Wide-field fundus photograph from neonatal ROP screening. Acquired on the Natus RetCam Envision:
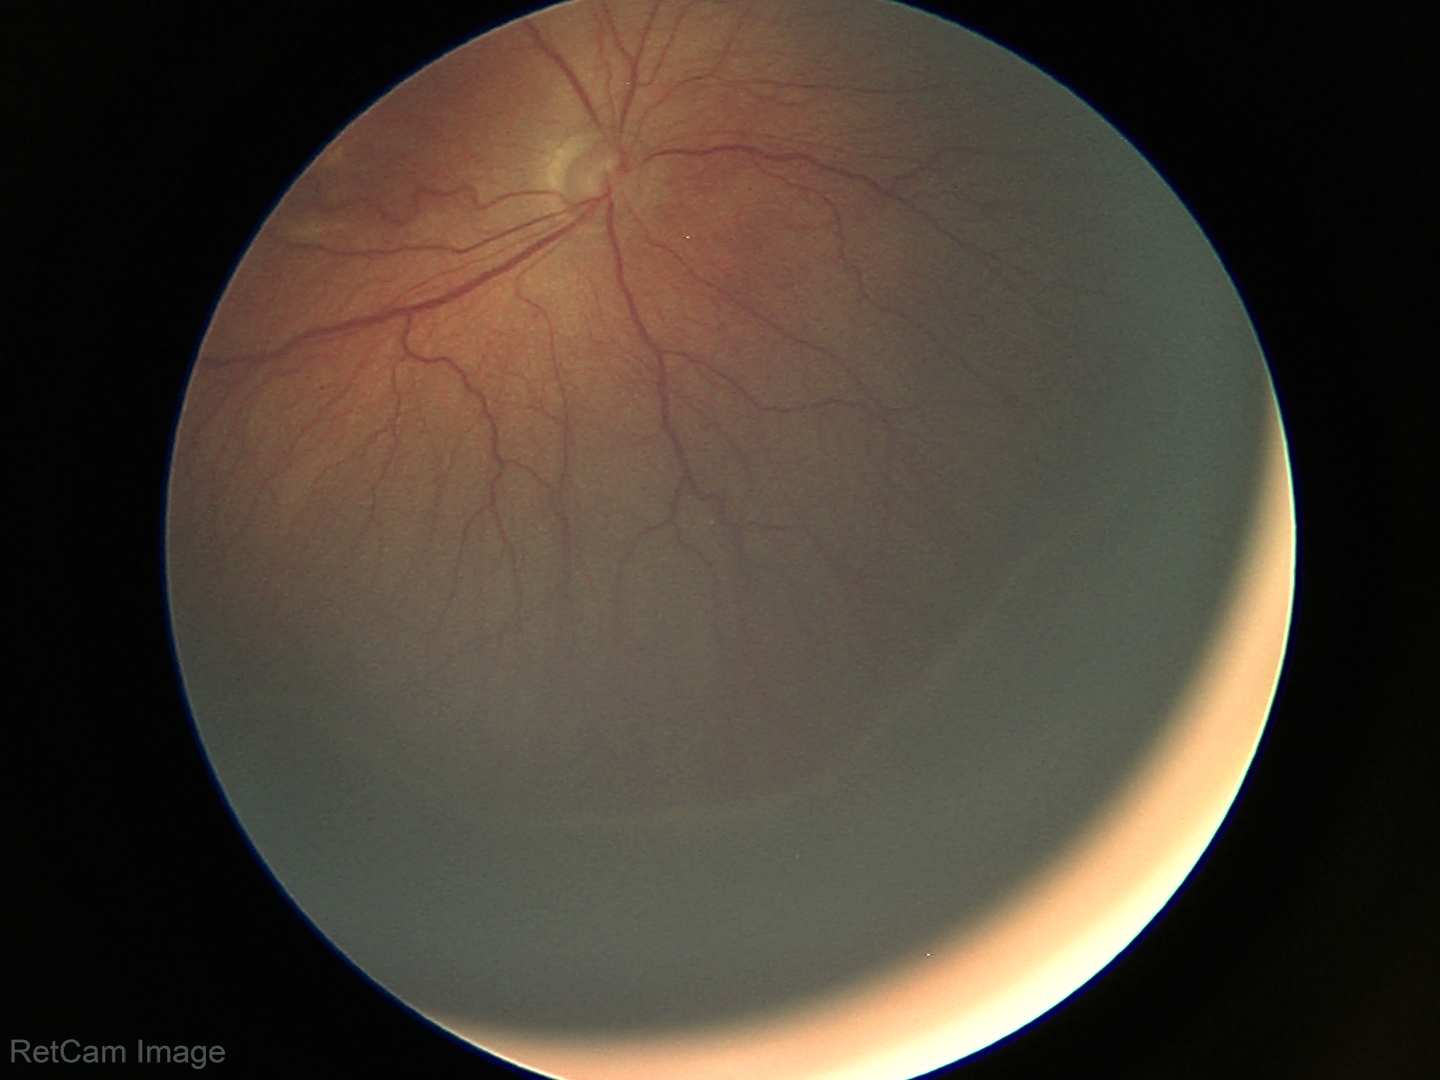
Screening series with retinopathy of prematurity (ROP) stage 3.